45° FOV, color fundus image, 2352 by 1568 pixels — 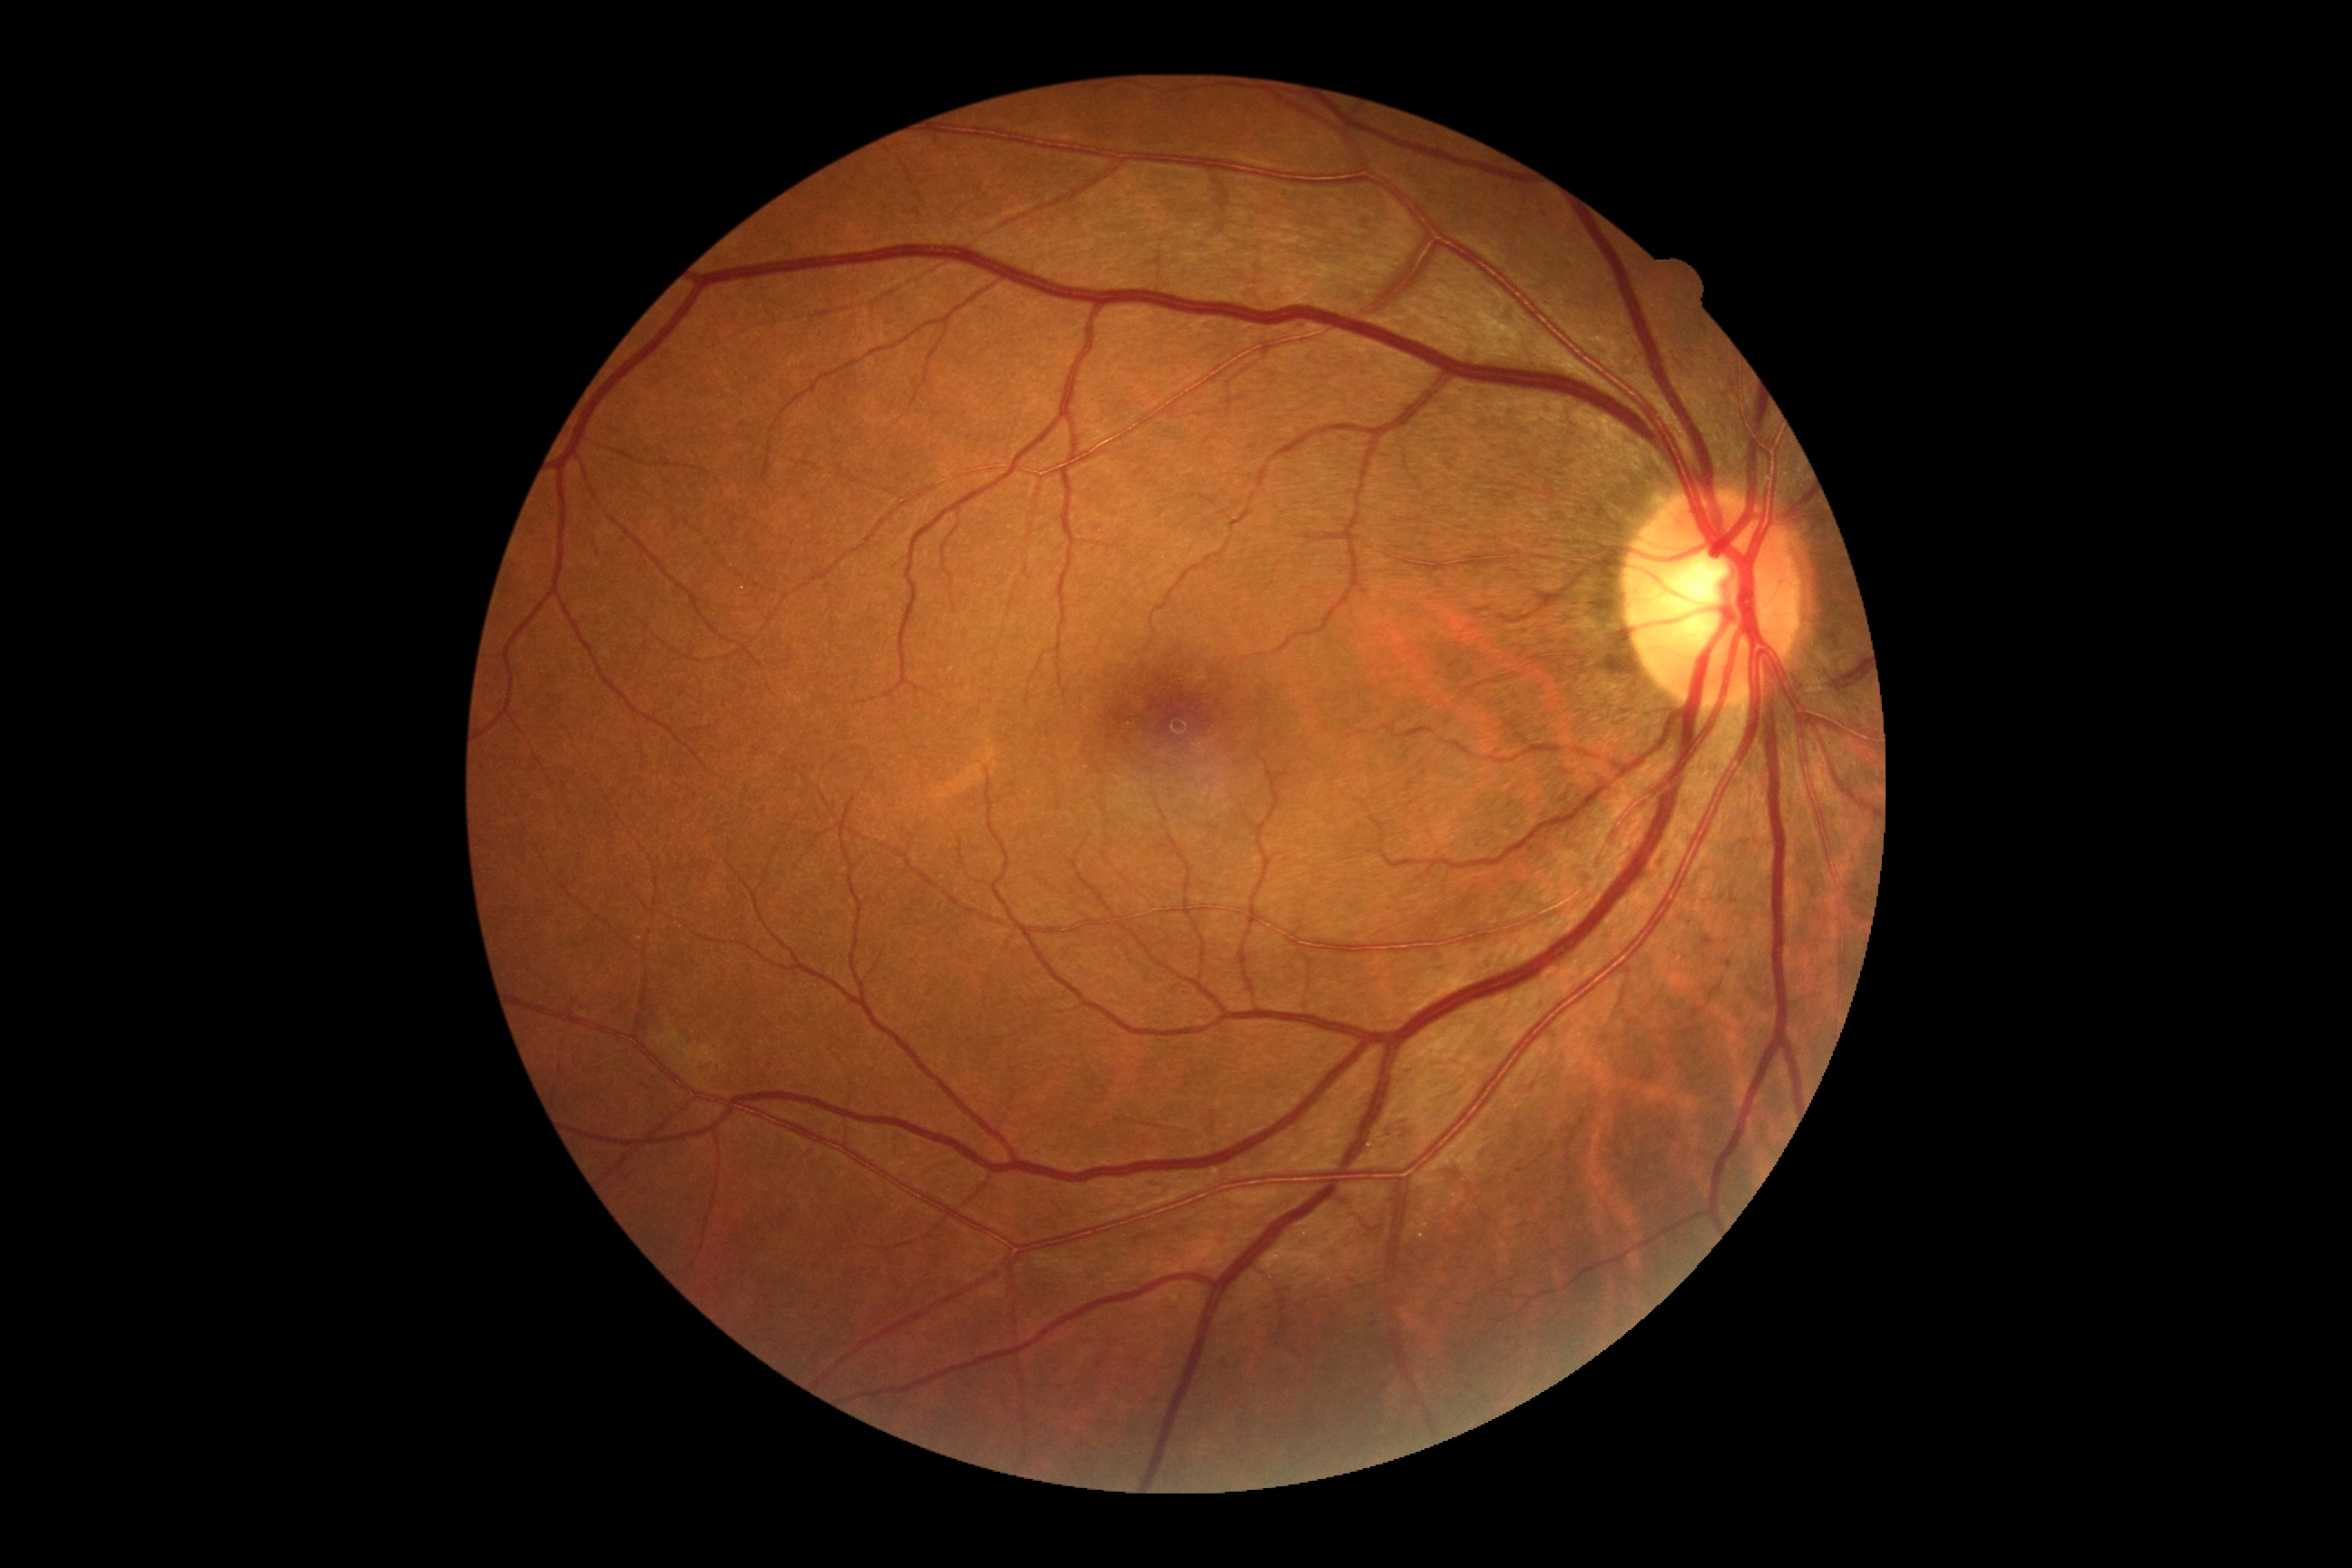
DR class: non-proliferative diabetic retinopathy. Diabetic retinopathy grade: moderate NPDR (2).